2352x1568
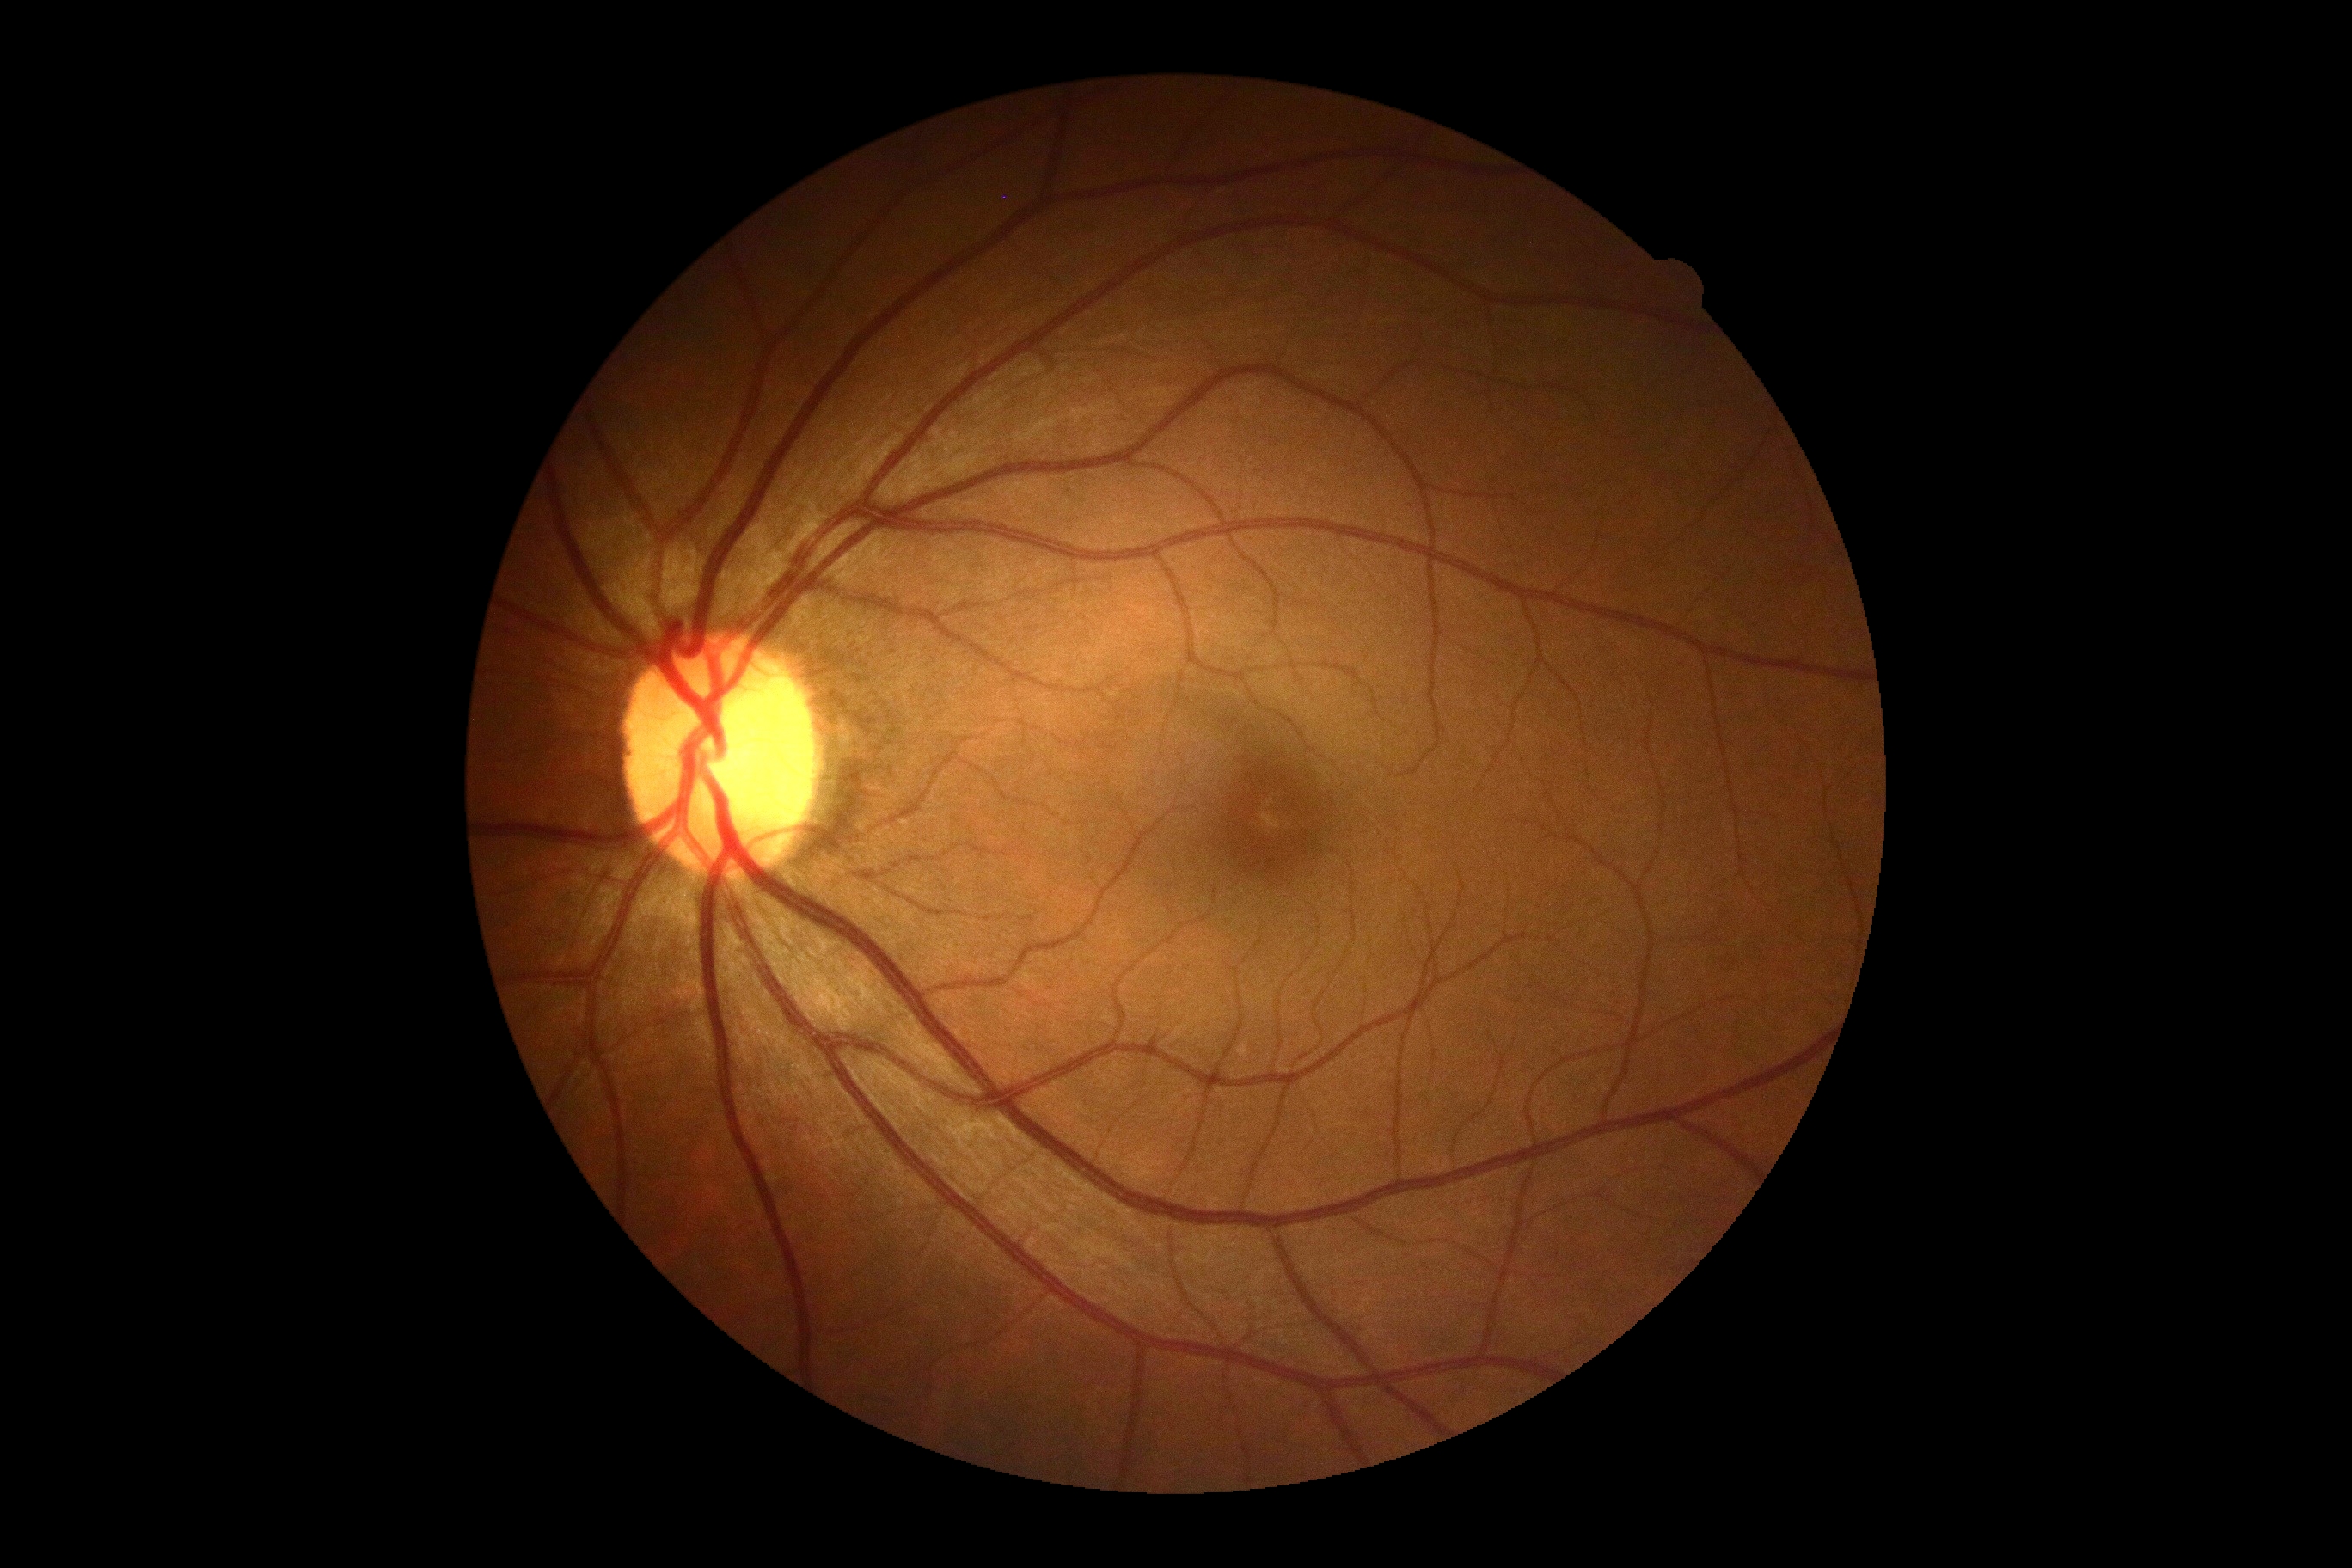
Diabetic retinopathy: no apparent diabetic retinopathy (grade 0). No DR findings.